Modified Davis classification
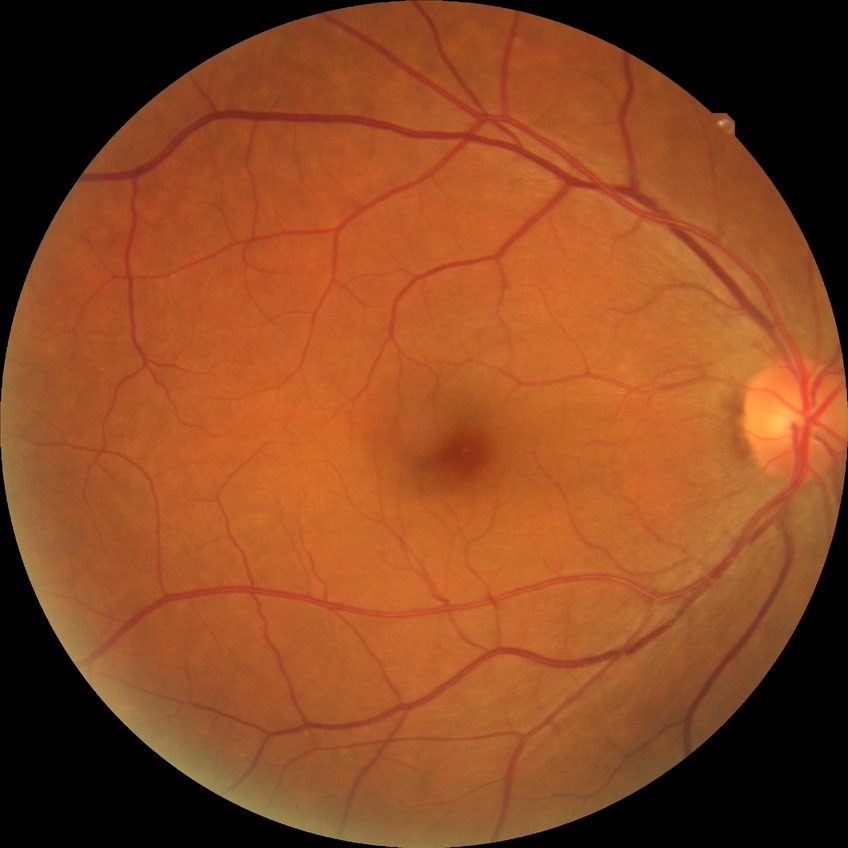 Modified Davis grading: no diabetic retinopathy.